2368 x 1568 pixels · fundus photo · 45-degree field of view.
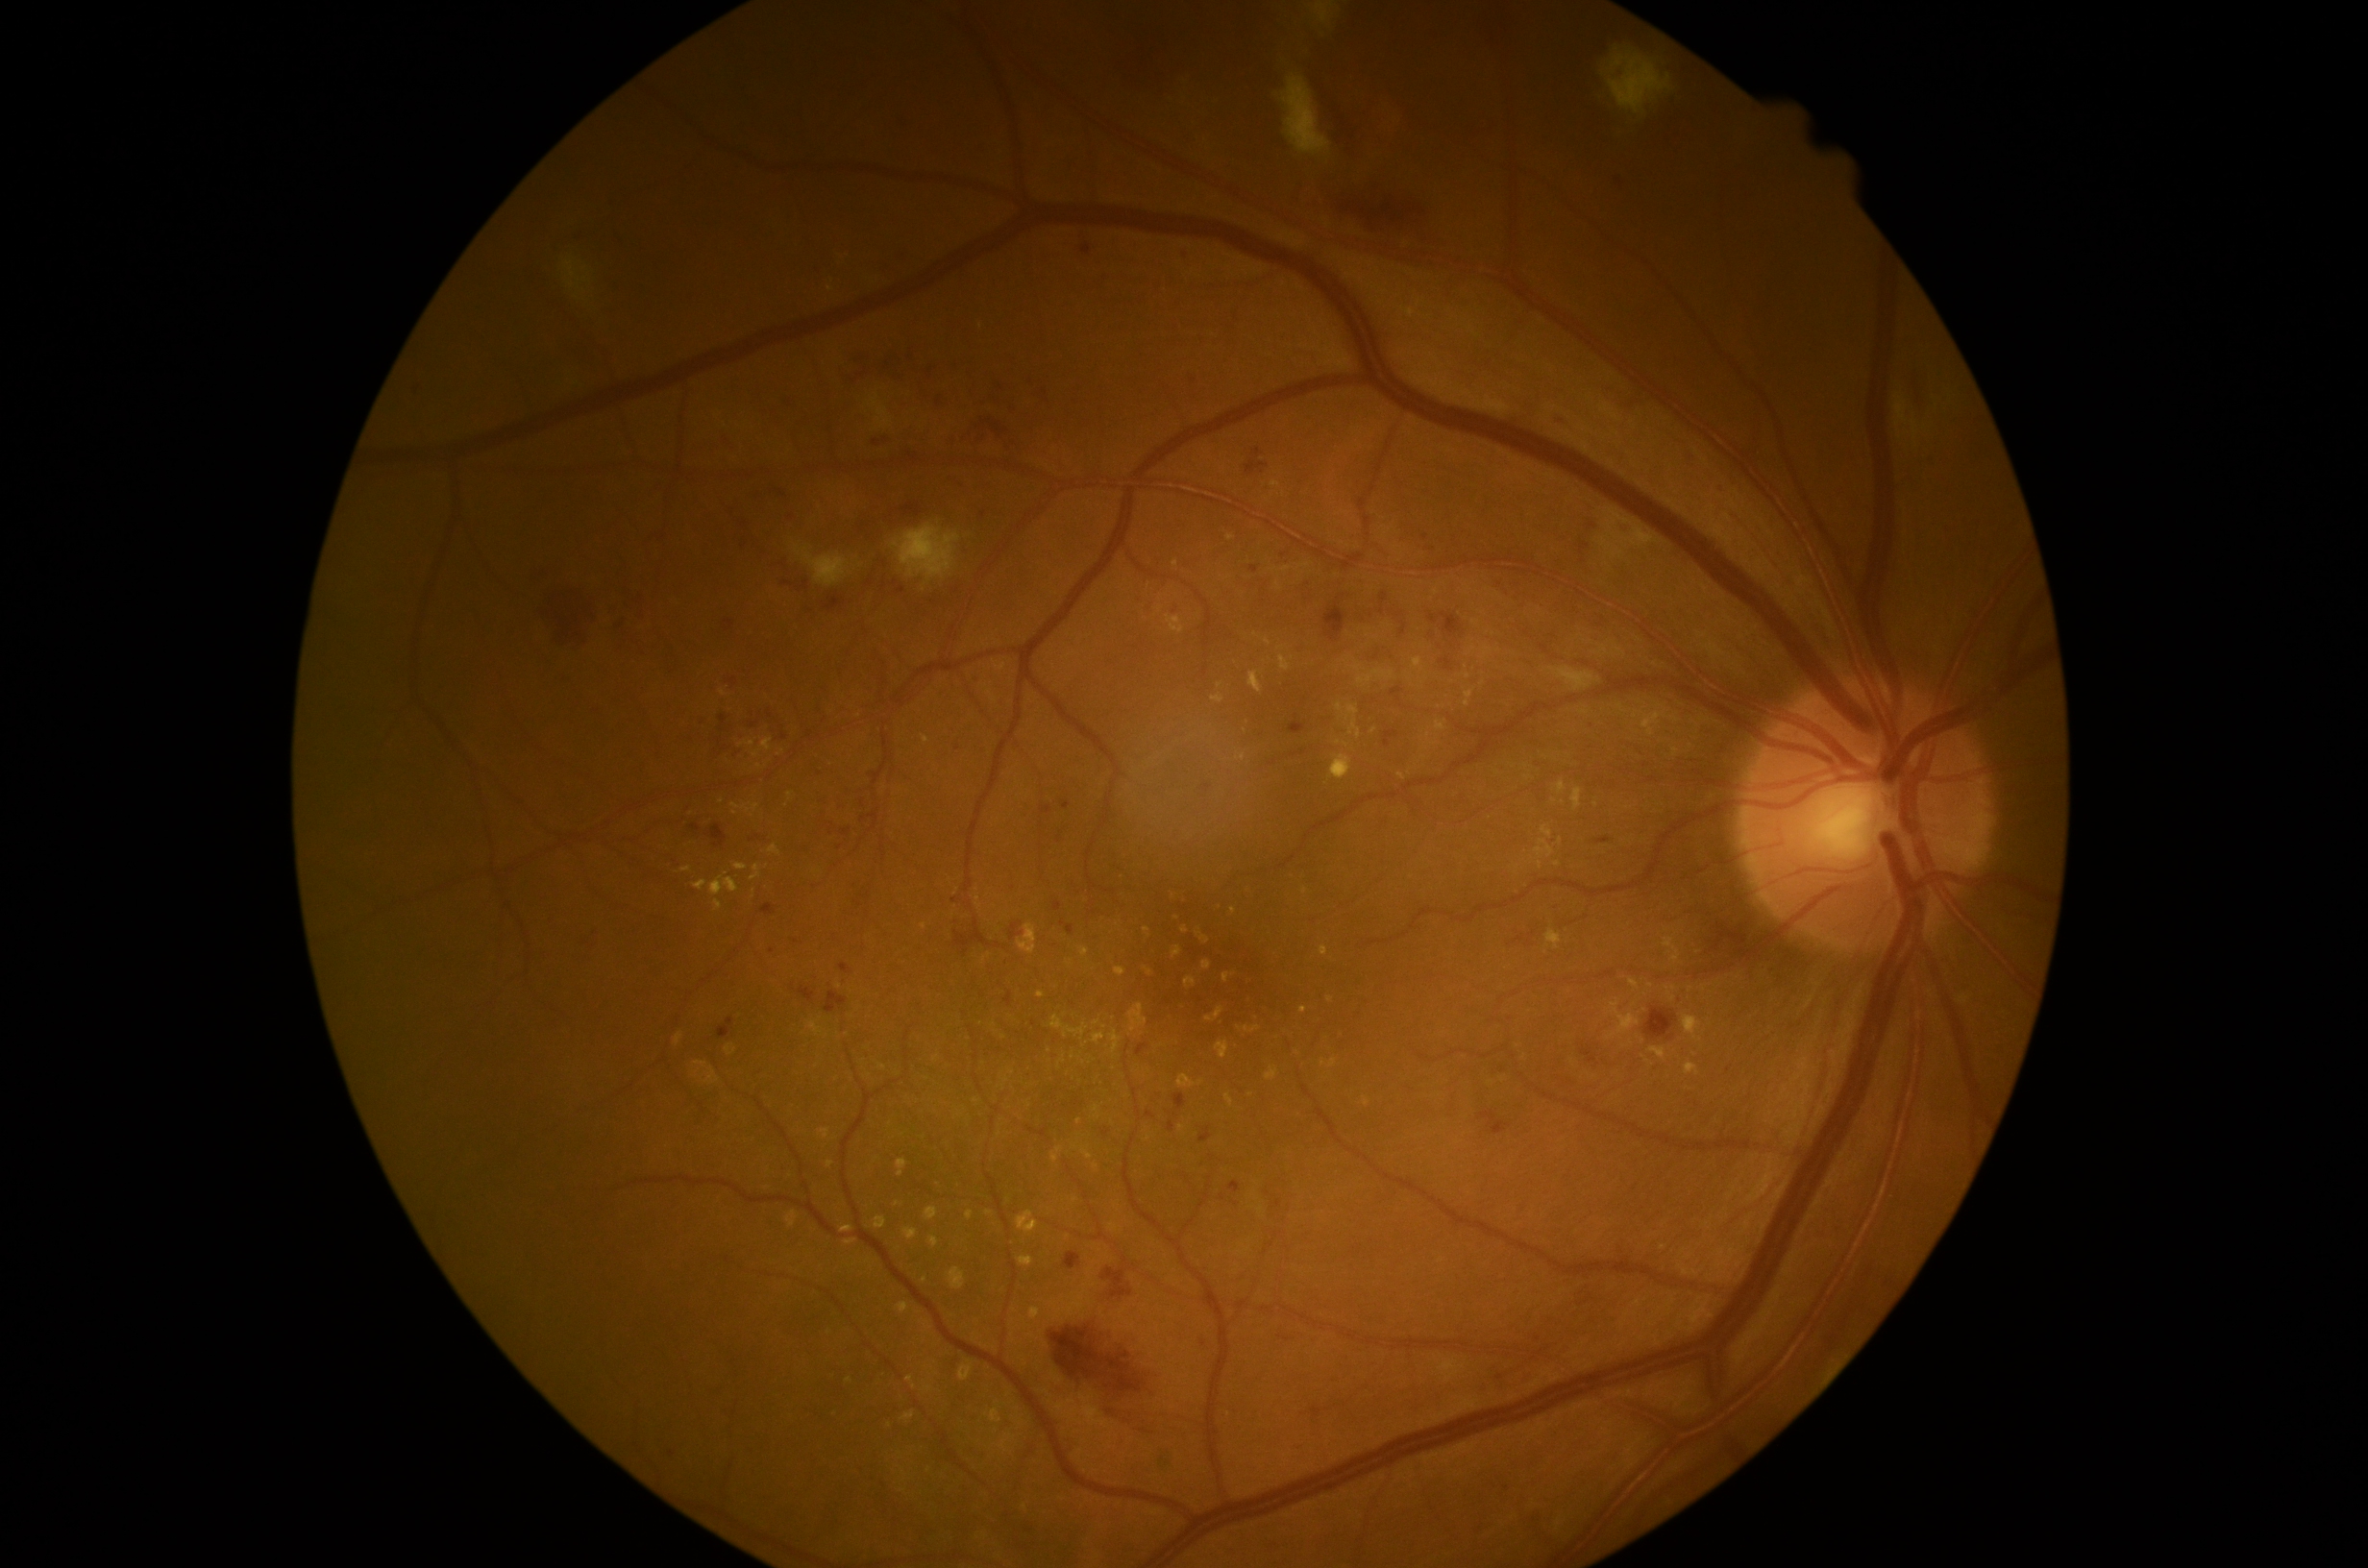 DR=grade 2 (moderate NPDR).